45° FOV
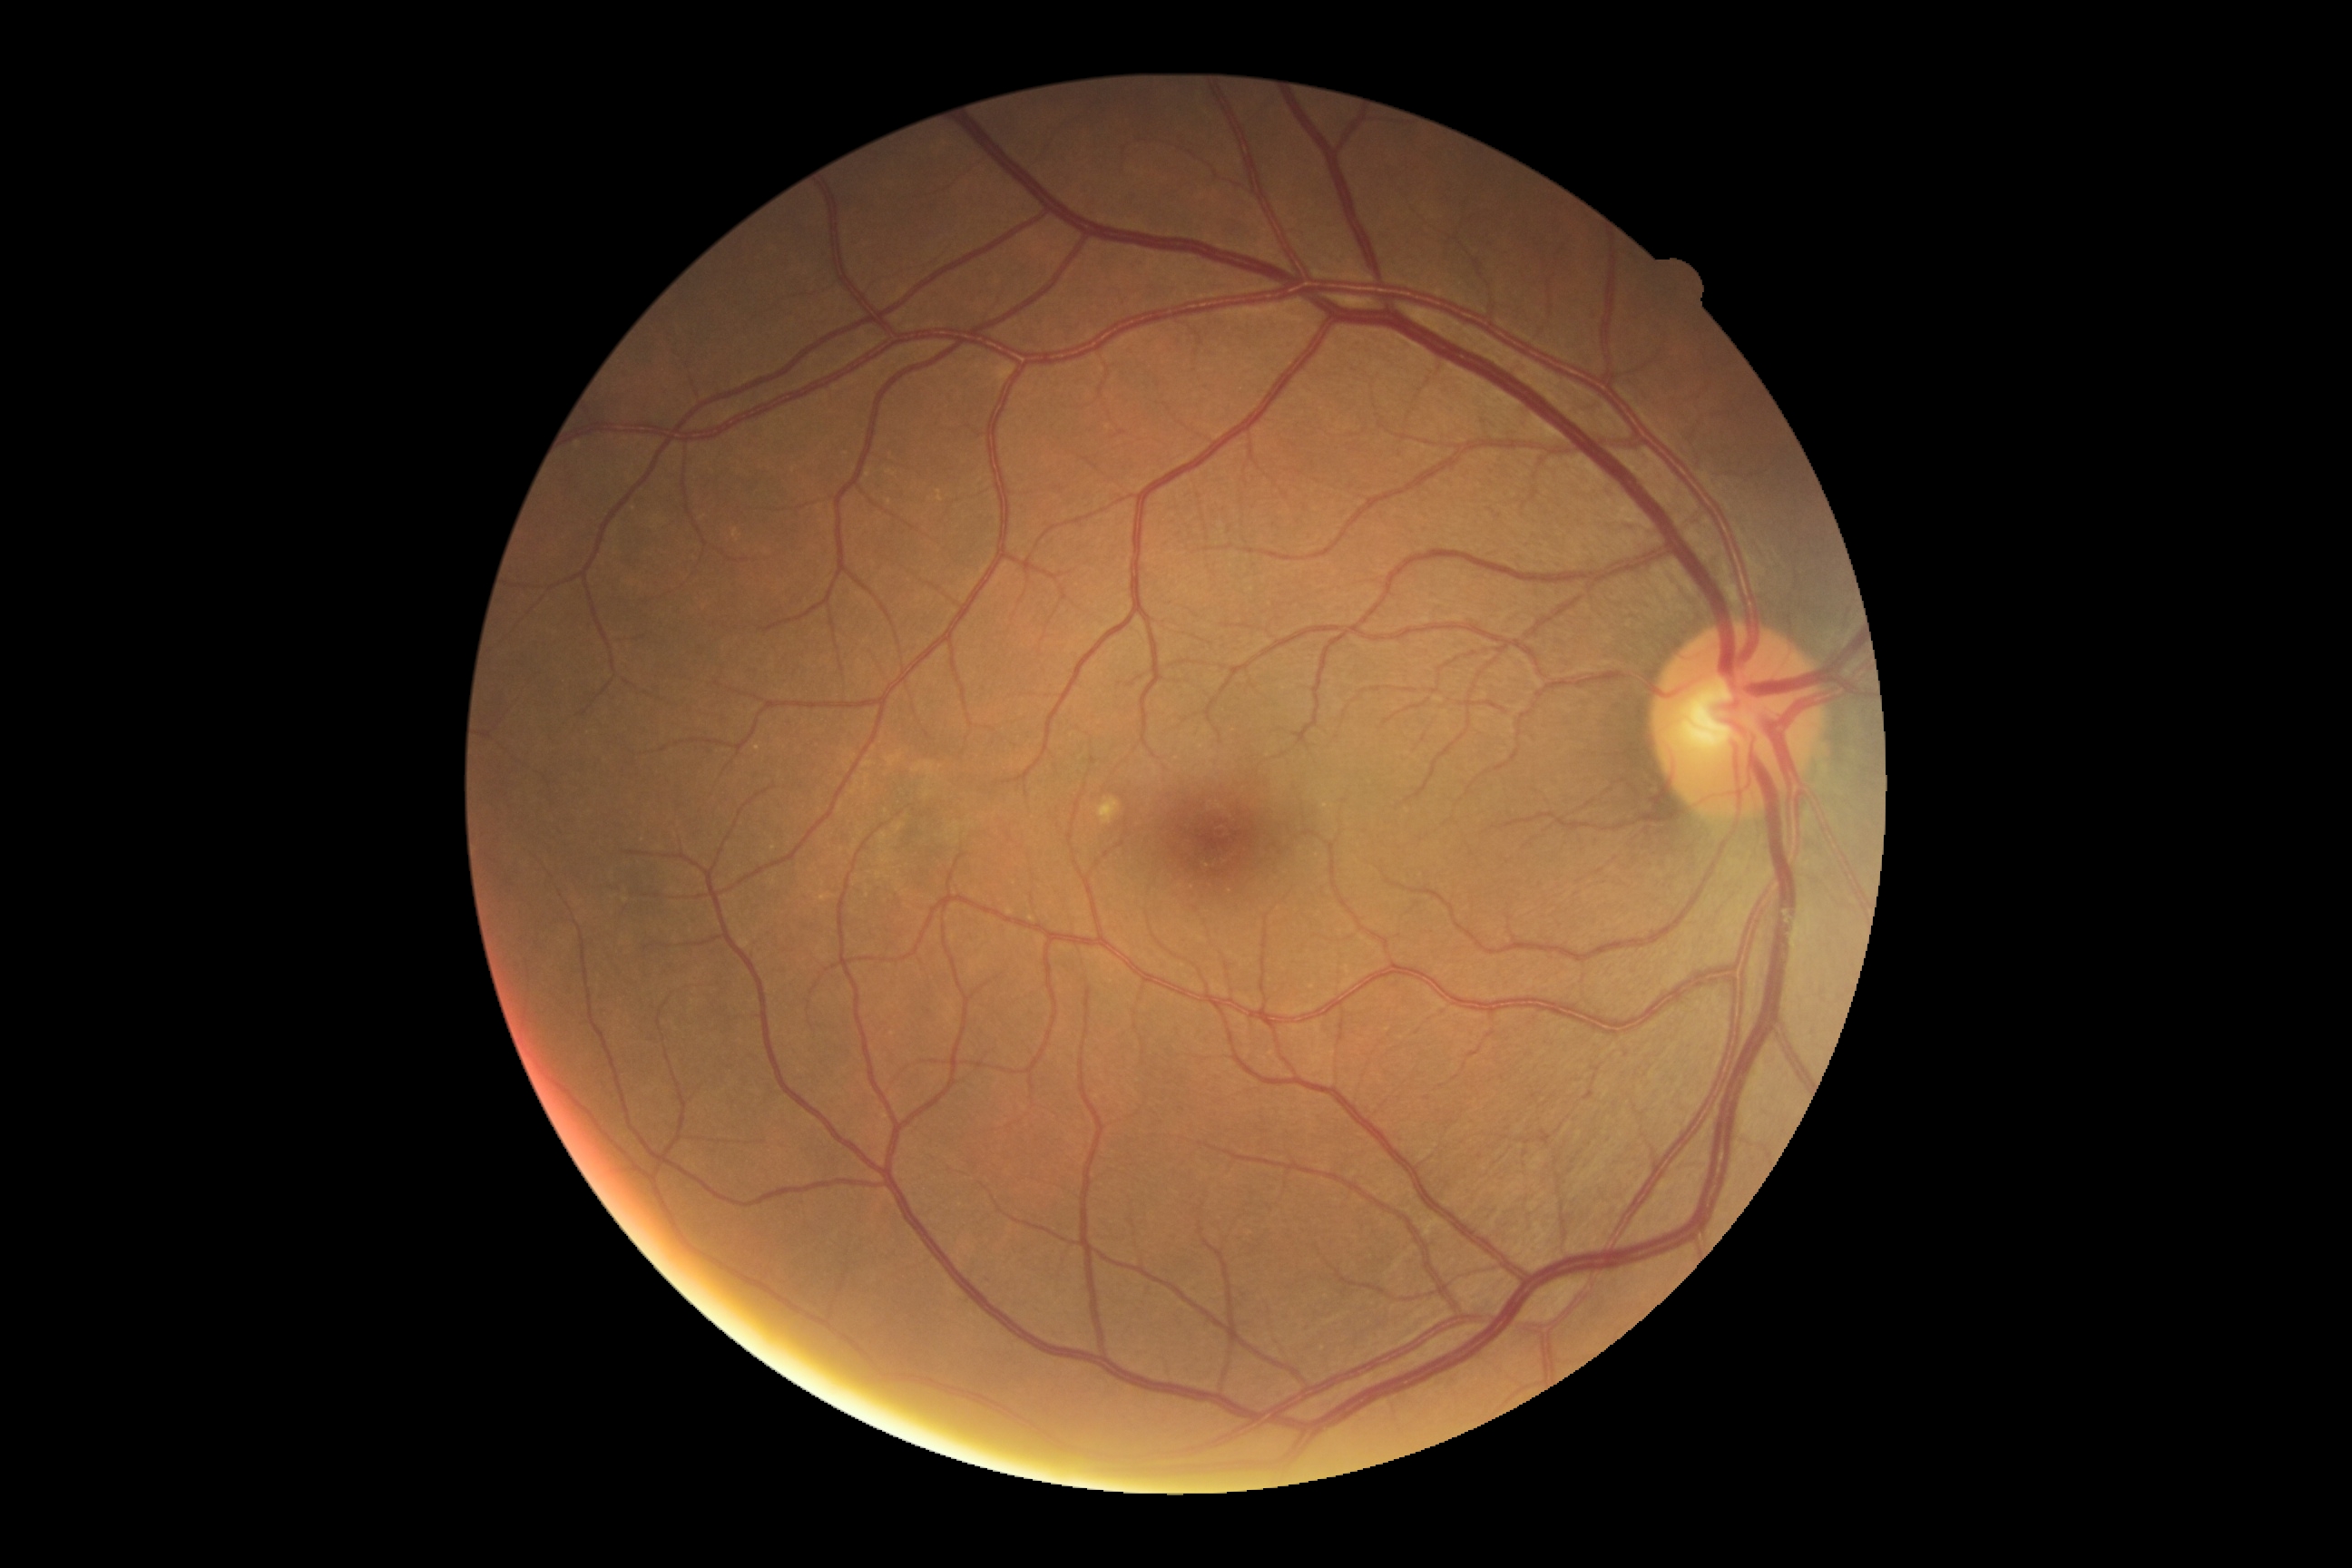 Retinopathy: grade 0 (no apparent retinopathy).